Fundus photo: 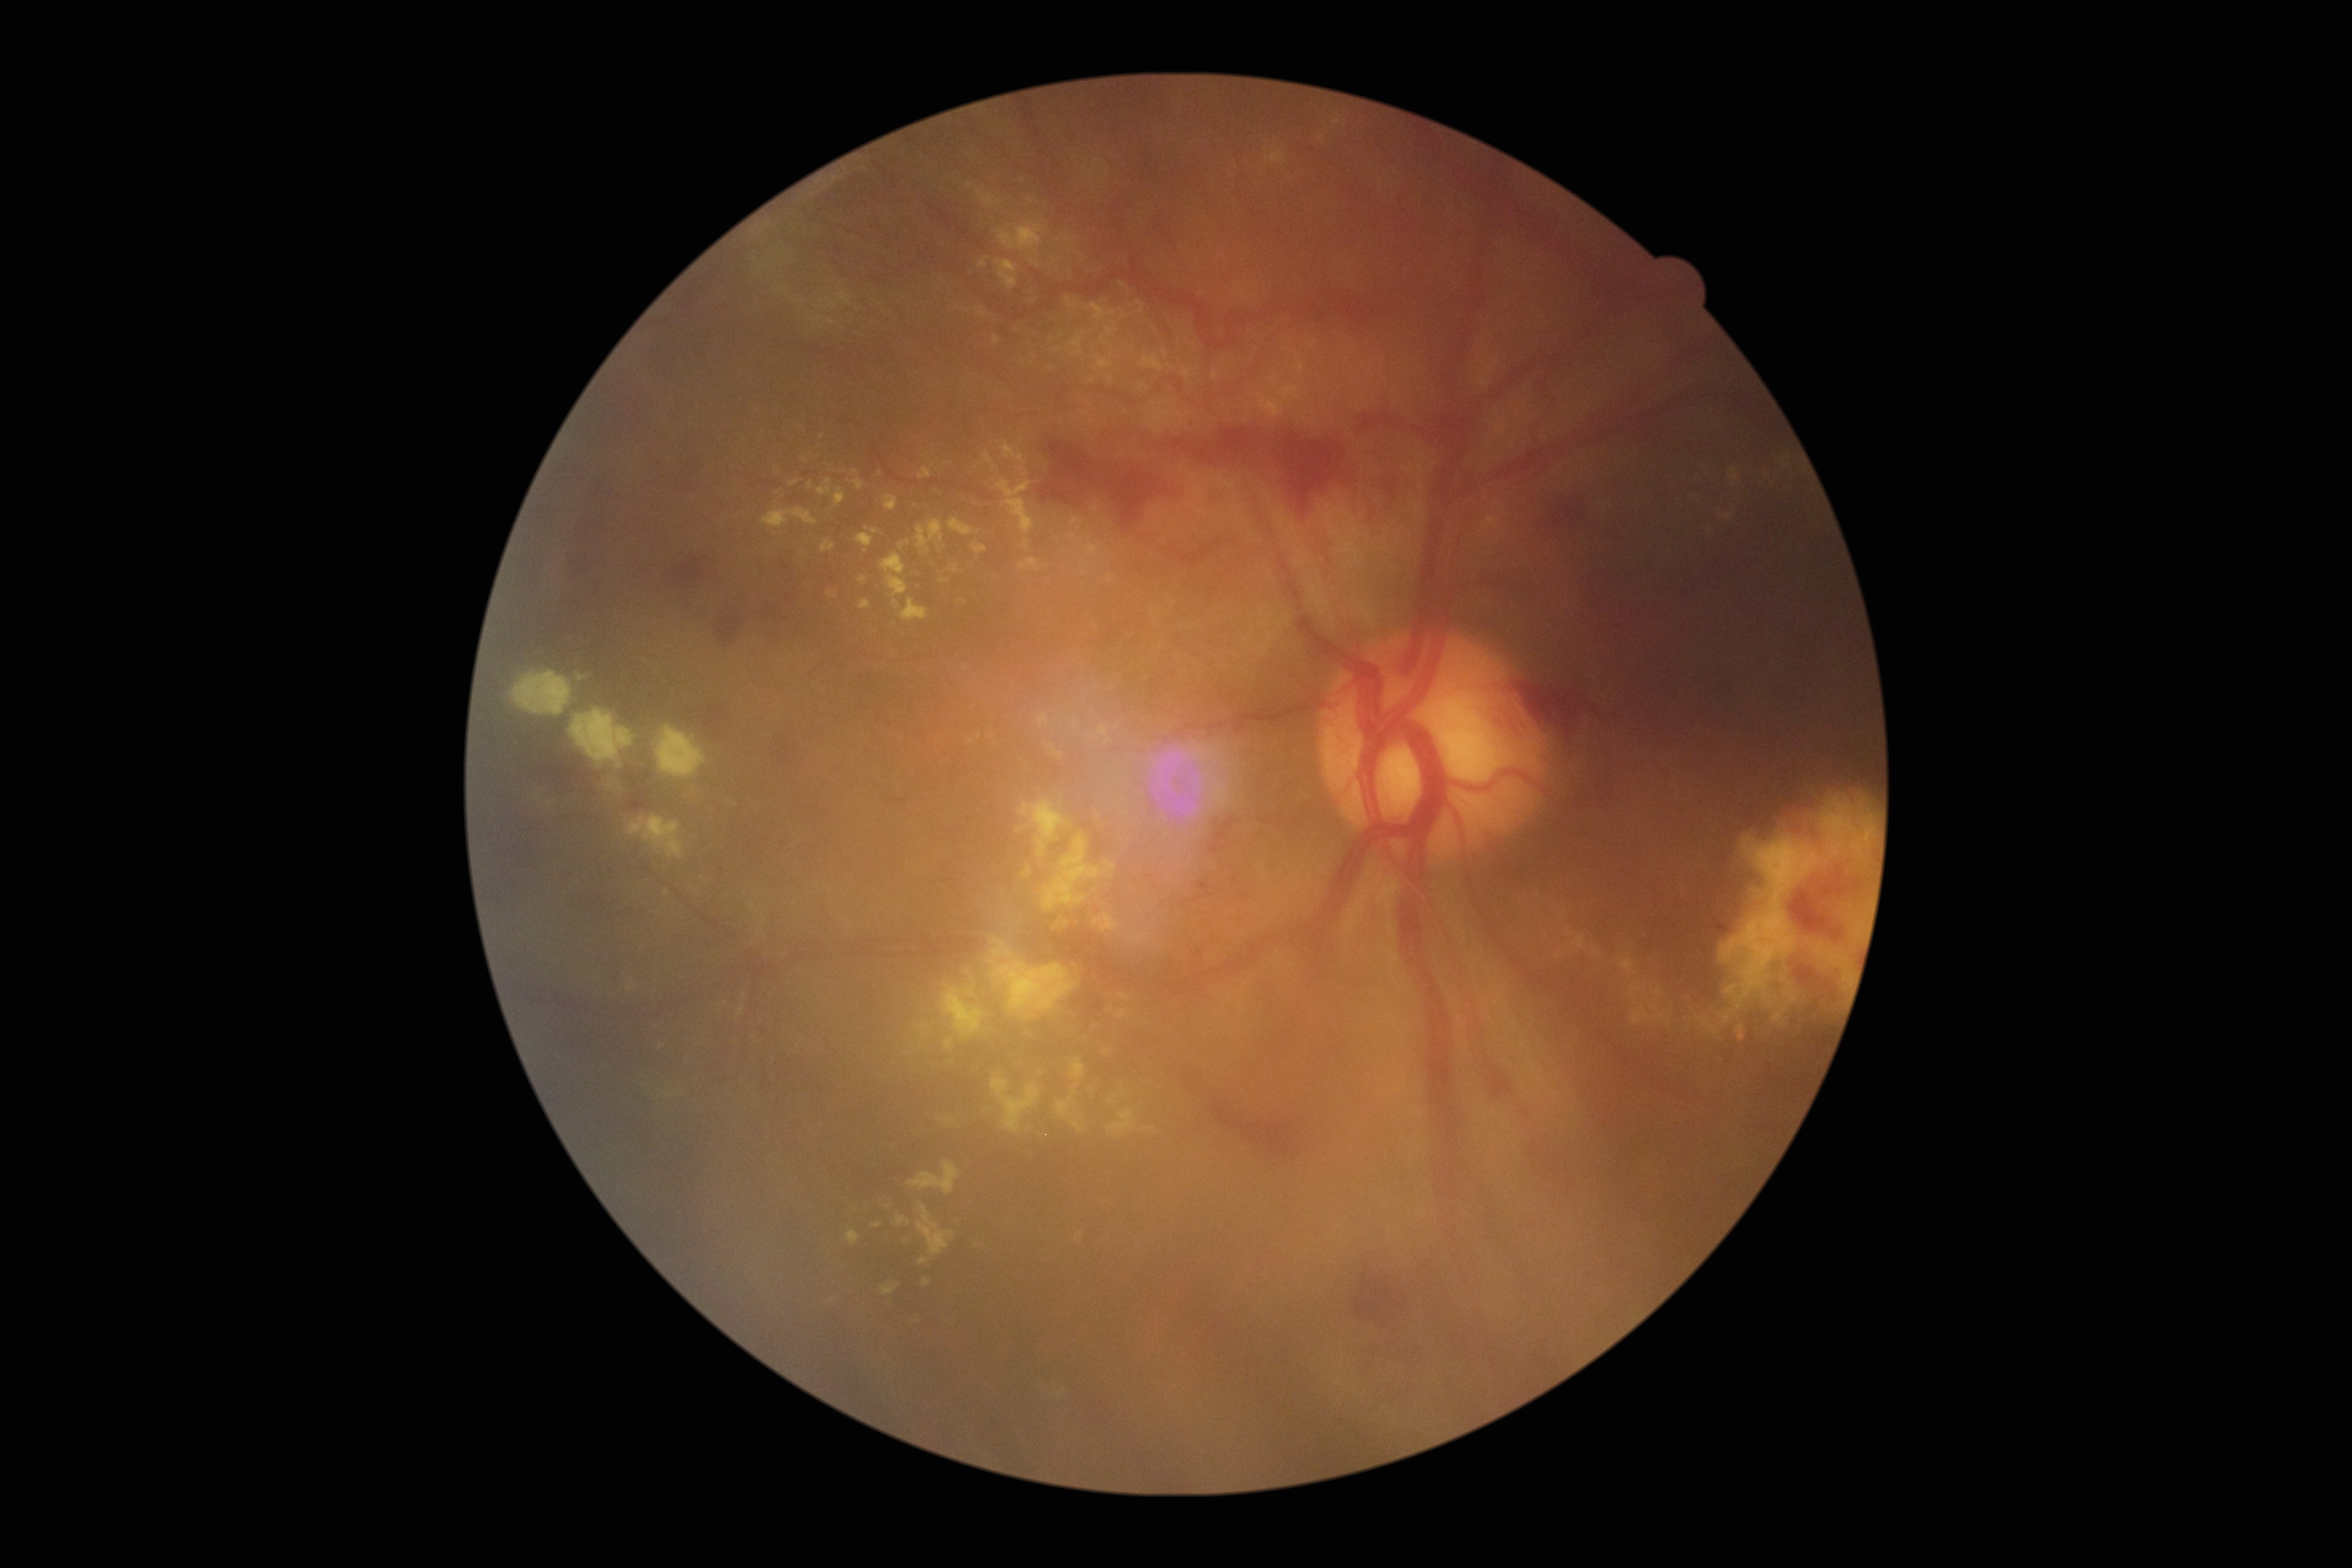 Diabetic retinopathy (DR): 4/4 — neovascularization and/or vitreous/pre-retinal hemorrhage.